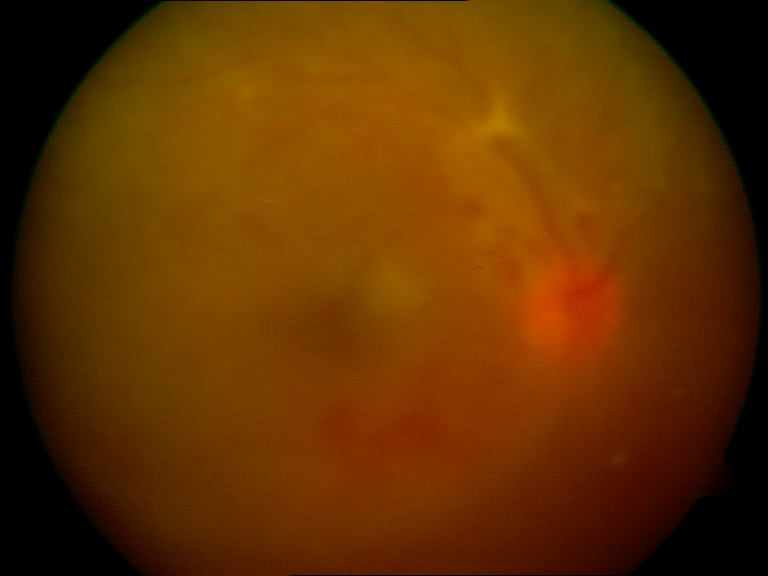 Gradability: significantly degraded. Proliferative retinopathy: features suspicious.